45-degree field of view · diabetic retinopathy graded by the modified Davis classification
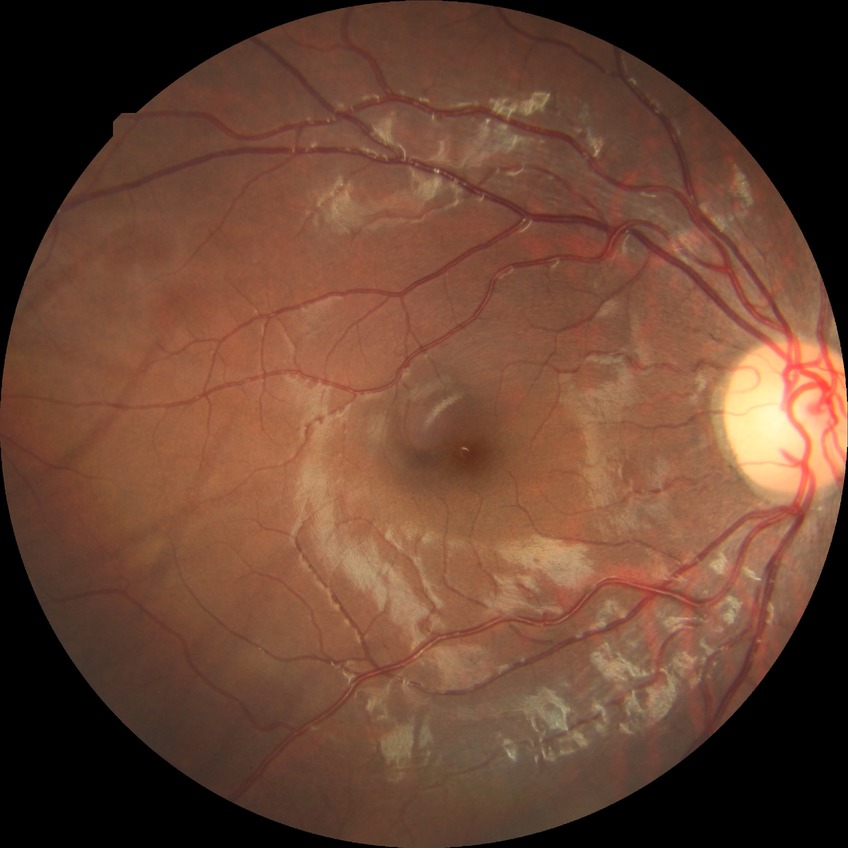
Diabetic retinopathy (DR): NDR (no diabetic retinopathy).